2352x1568px · fundus photo · FOV: 45 degrees — 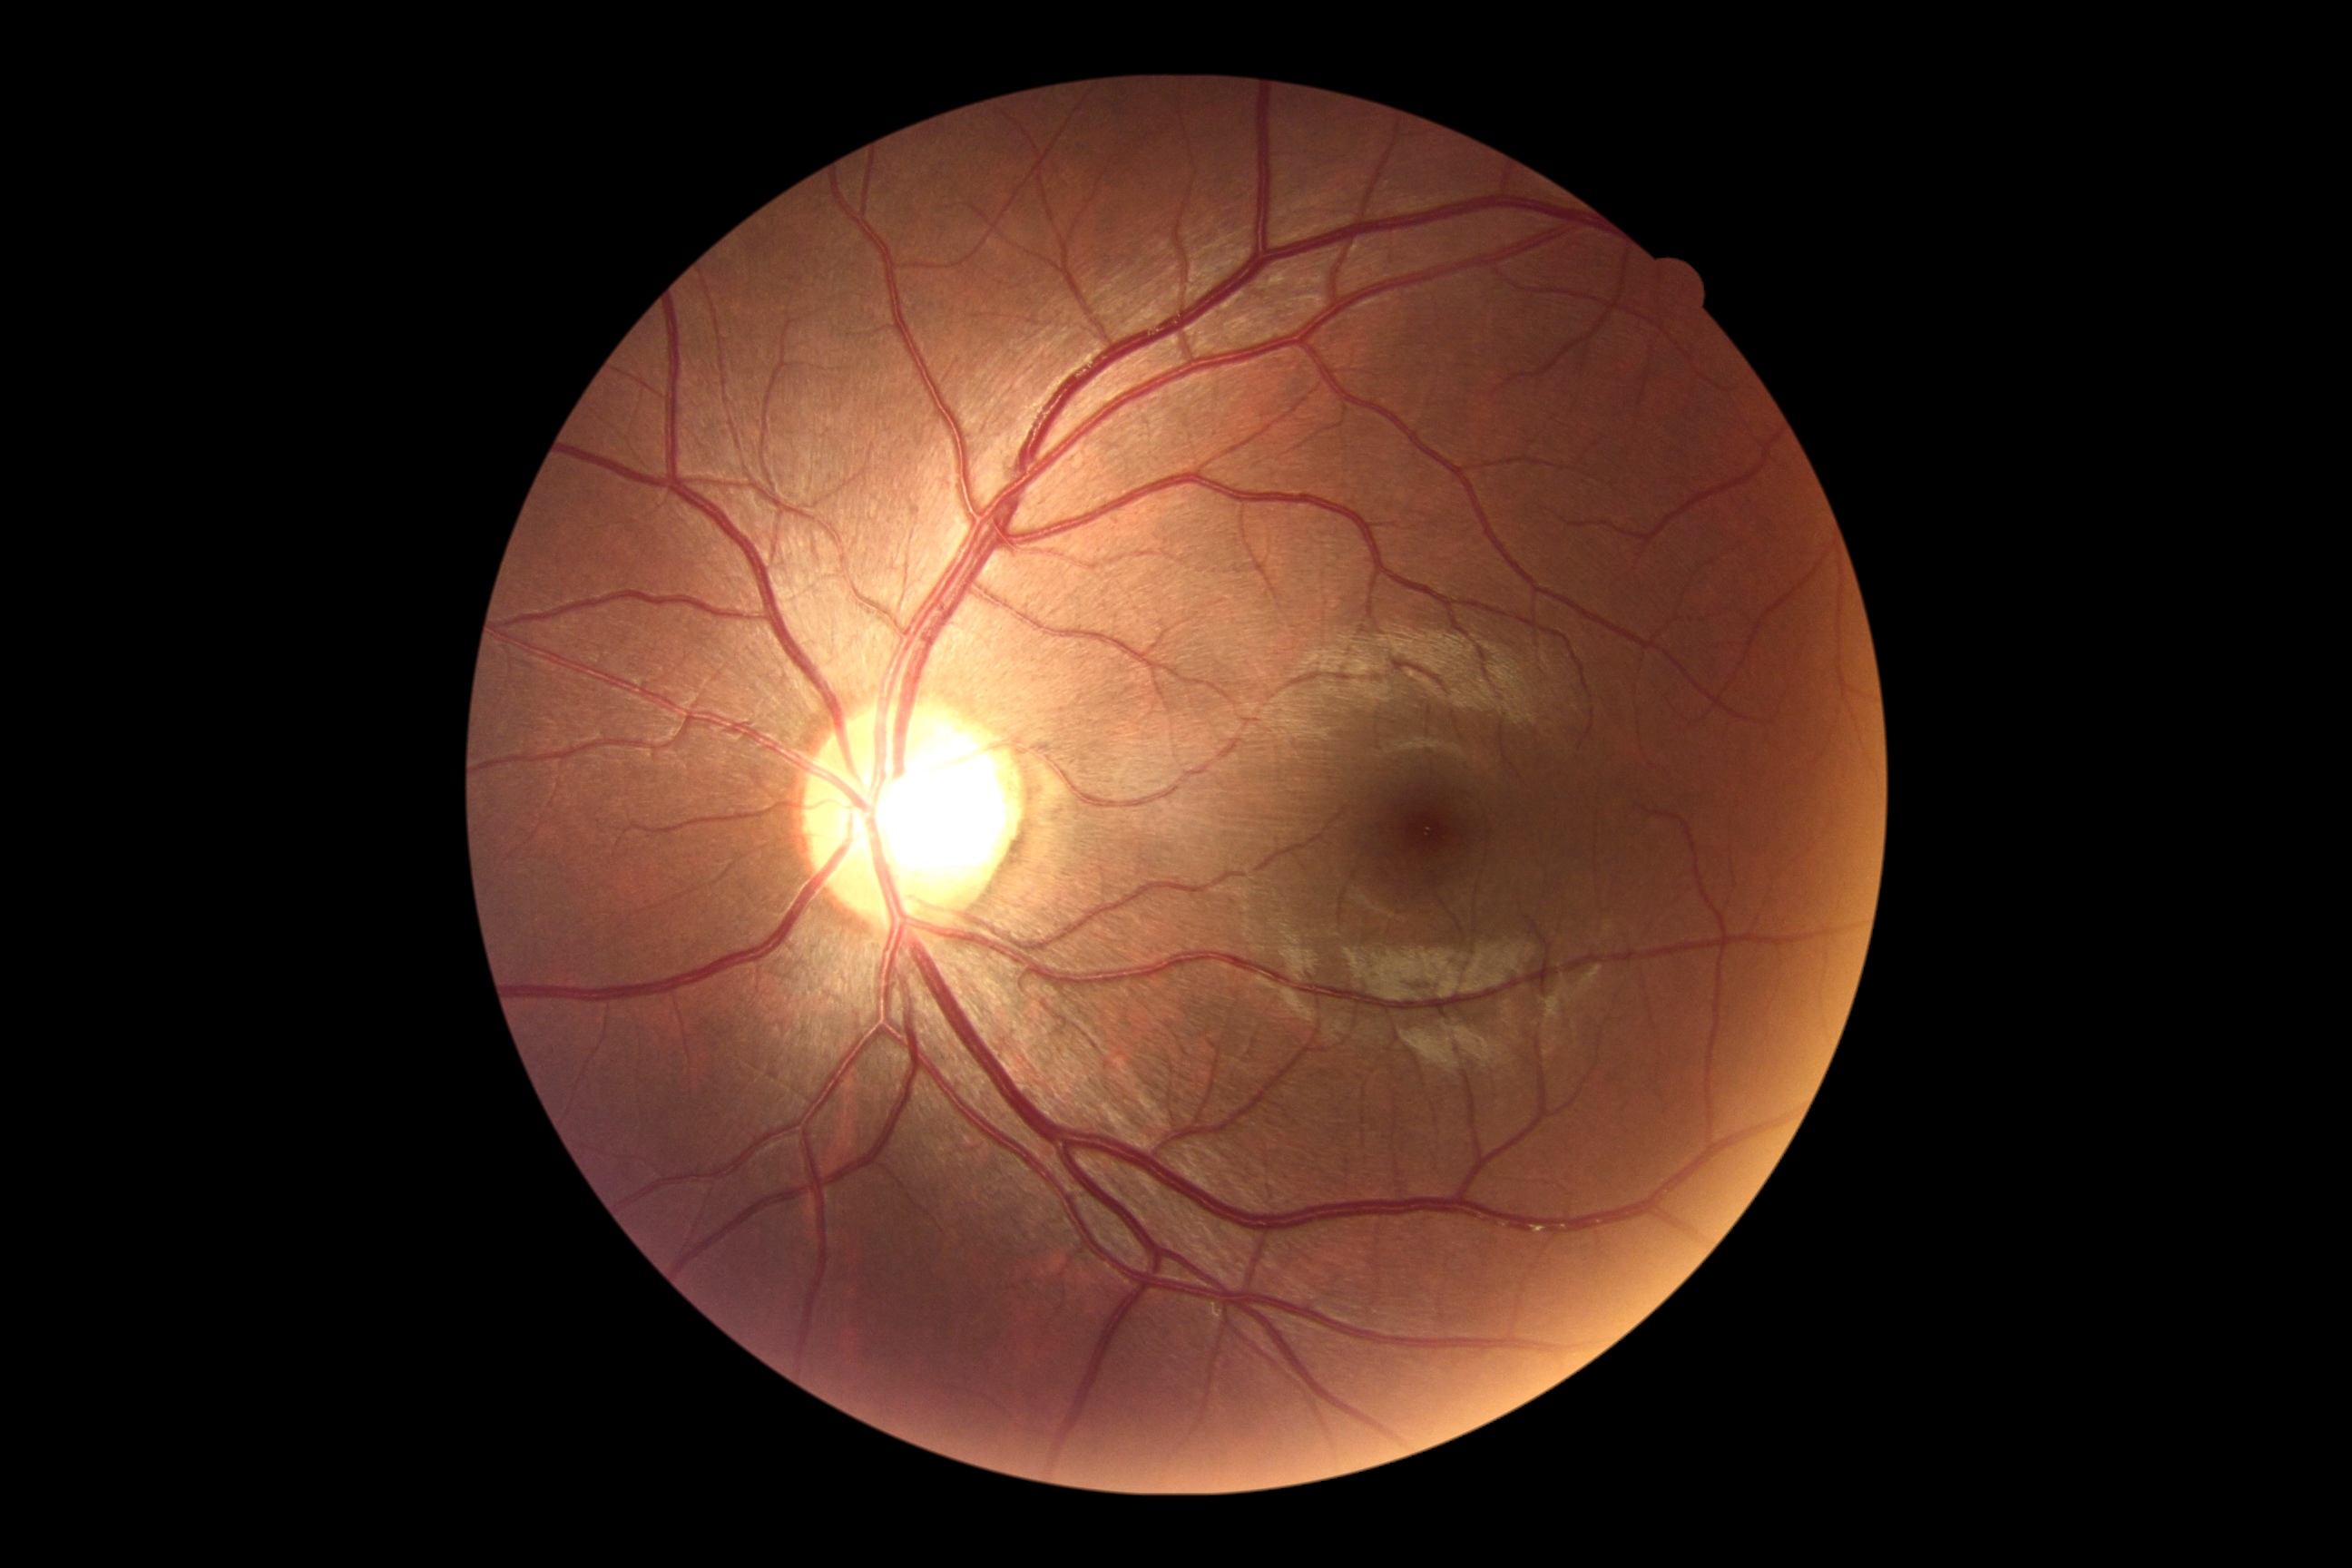 DR severity is no apparent retinopathy (grade 0).